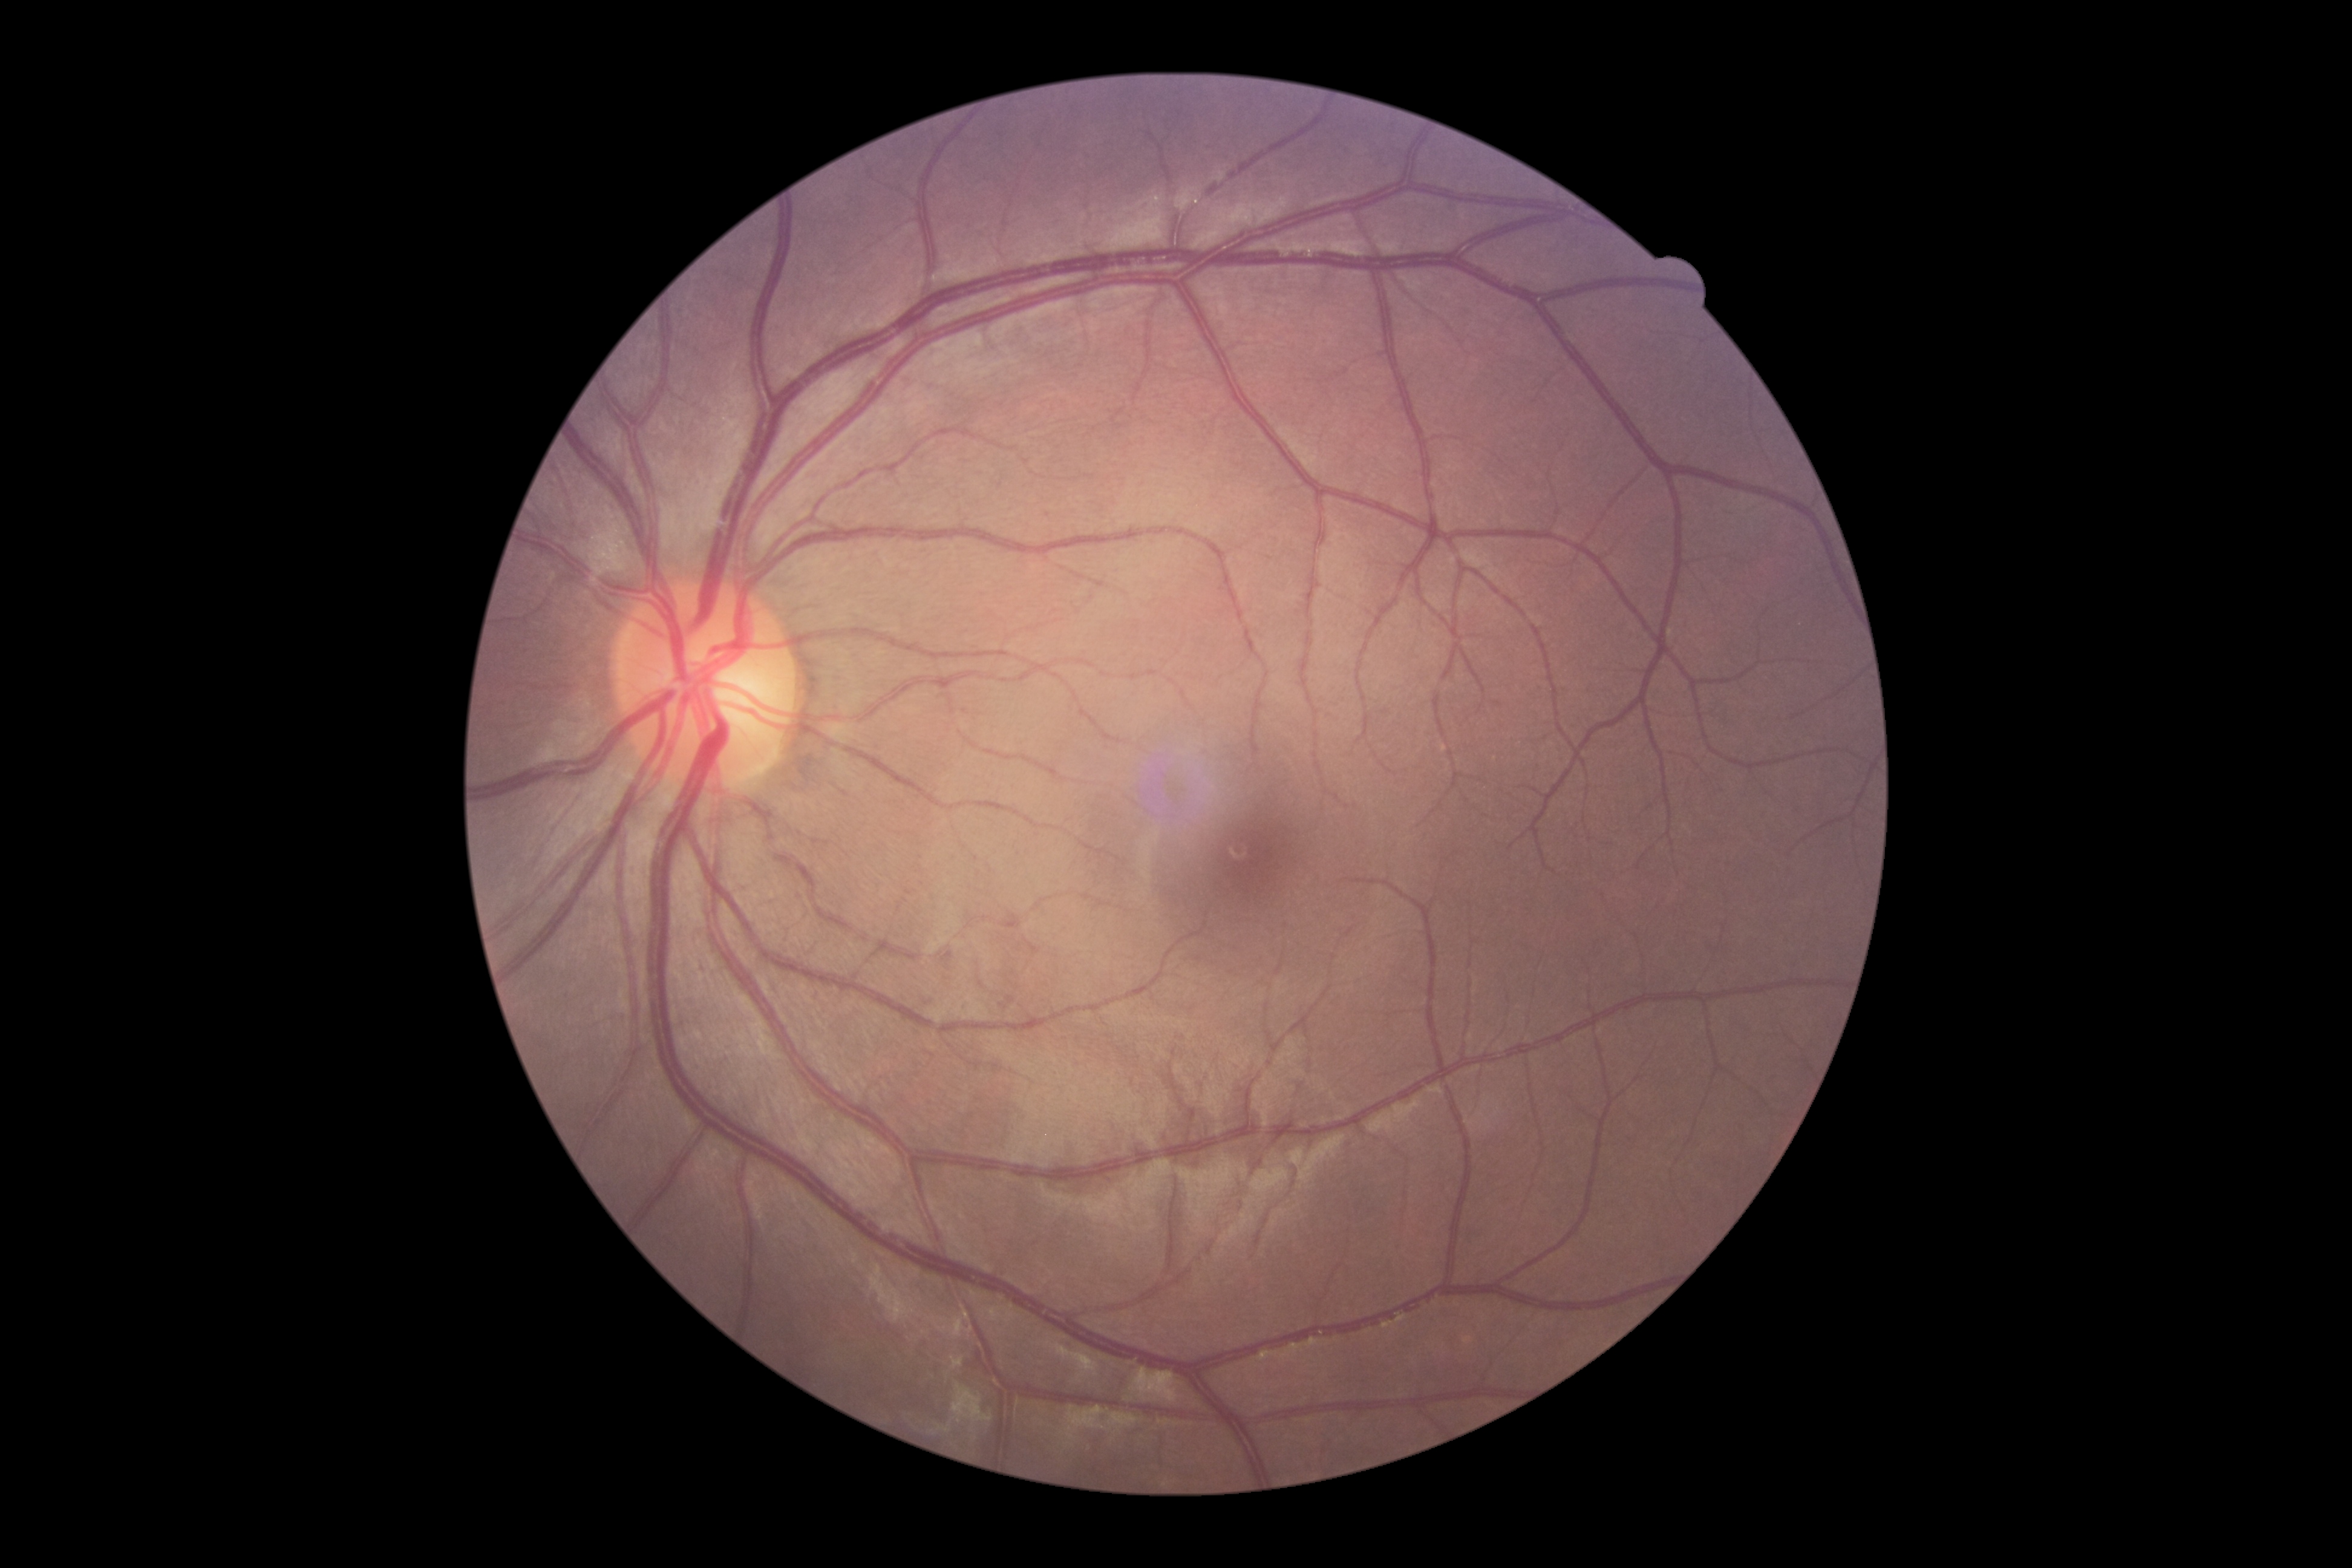

Diabetic retinopathy is grade 0 (no apparent retinopathy).
No signs of diabetic retinopathy.